Modified Davis classification: 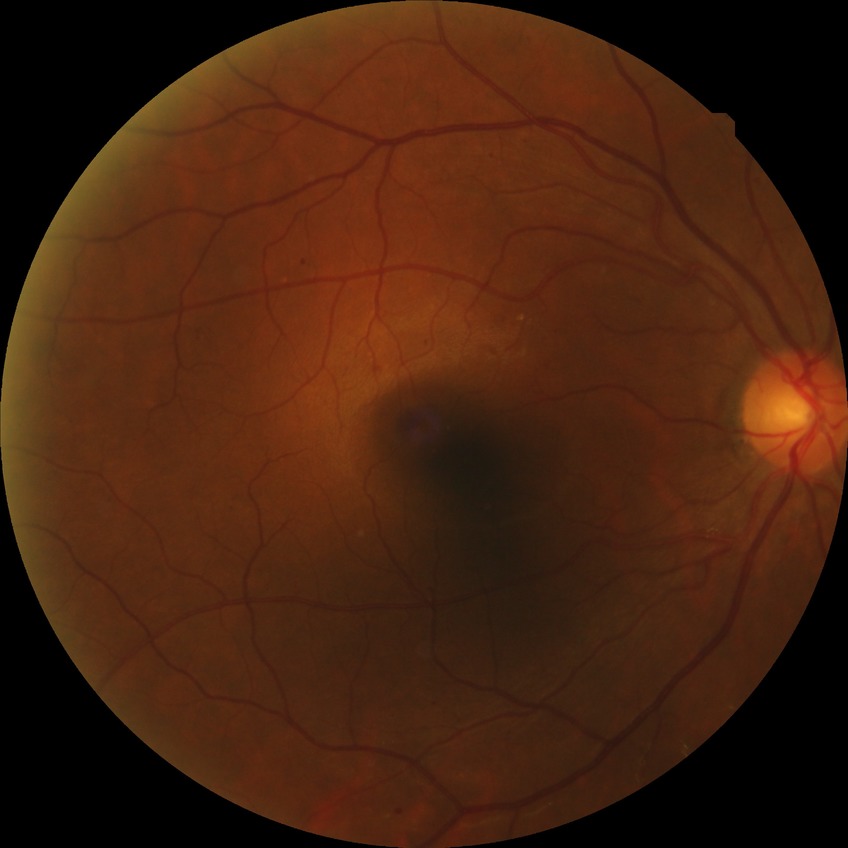 modified Davis grade=SDR.